Infant wide-field retinal image; camera: Clarity RetCam 3 (130° FOV); 640x480px
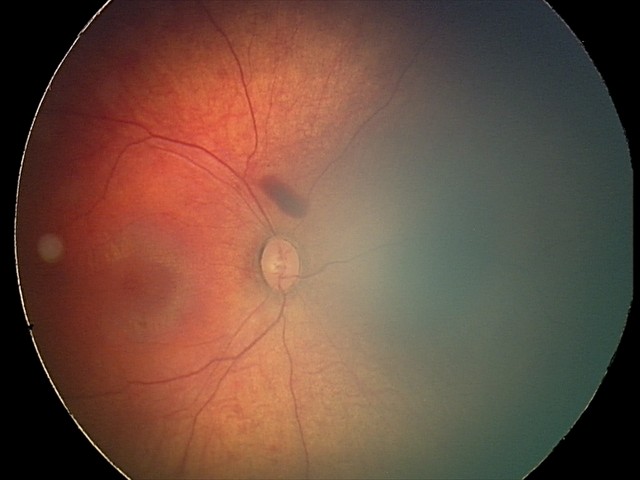
Examination diagnosed as retinal hemorrhages.